Fundus photo: 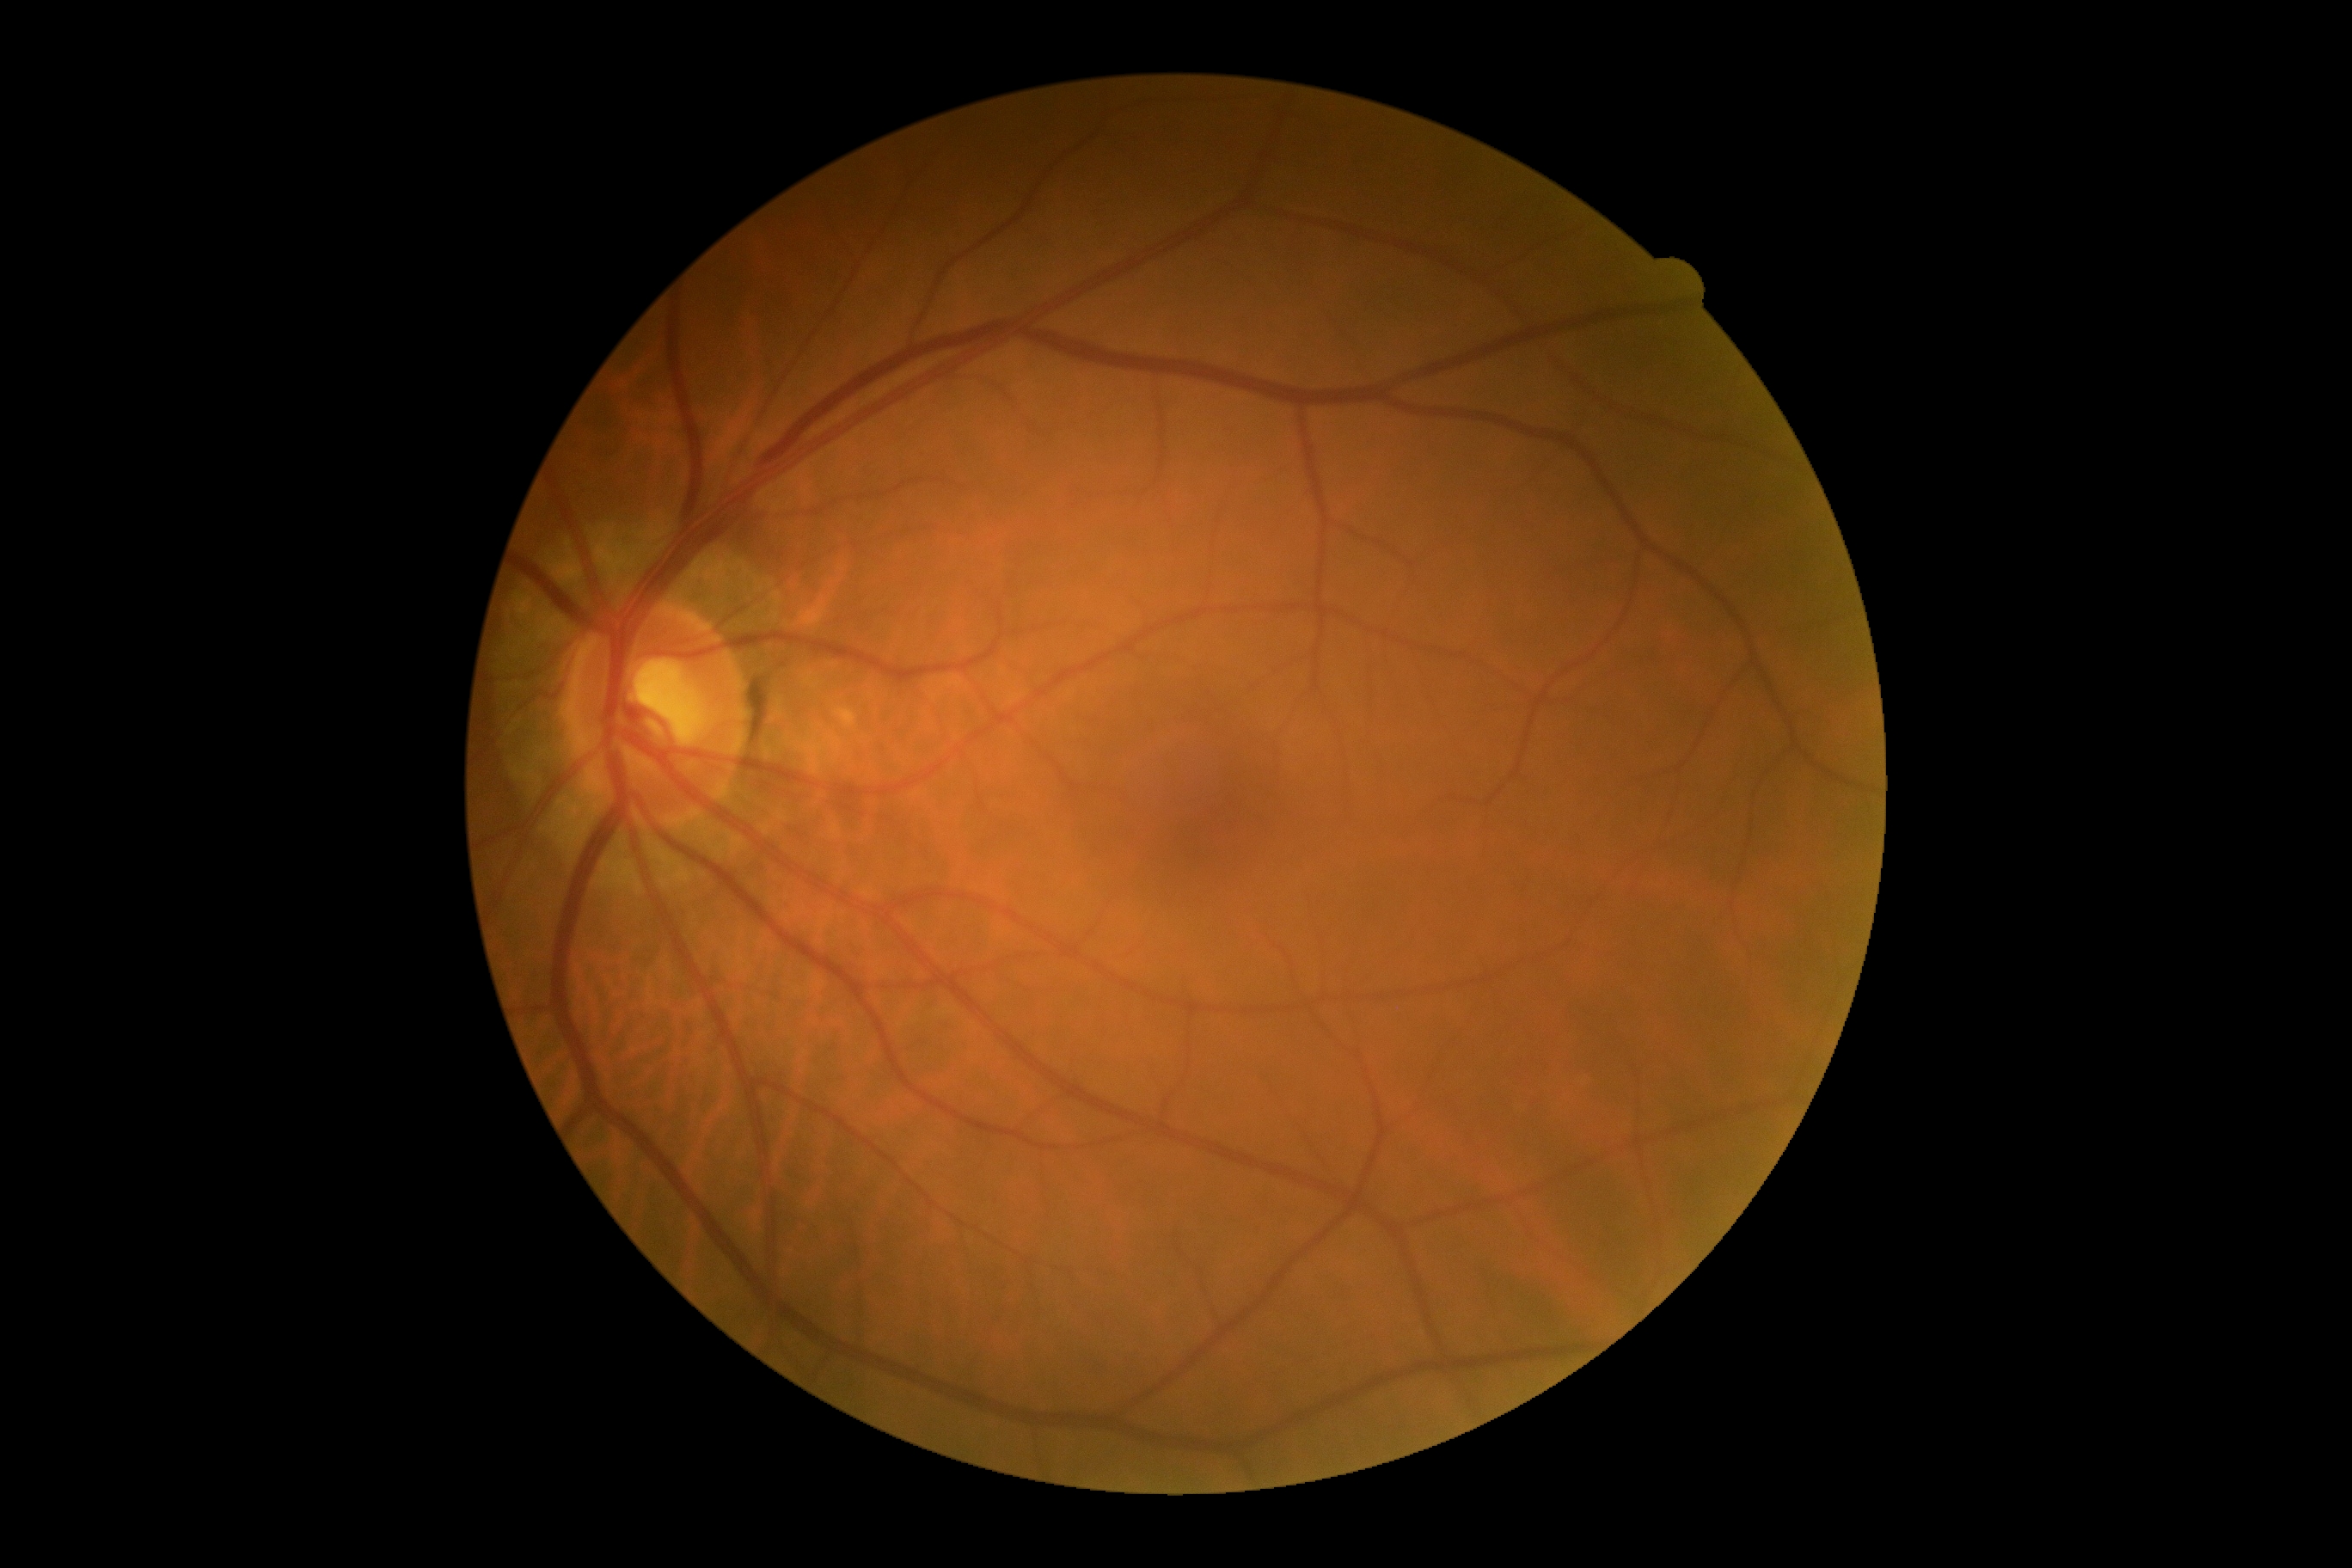 diabetic retinopathy severity: grade 0 (no apparent retinopathy).